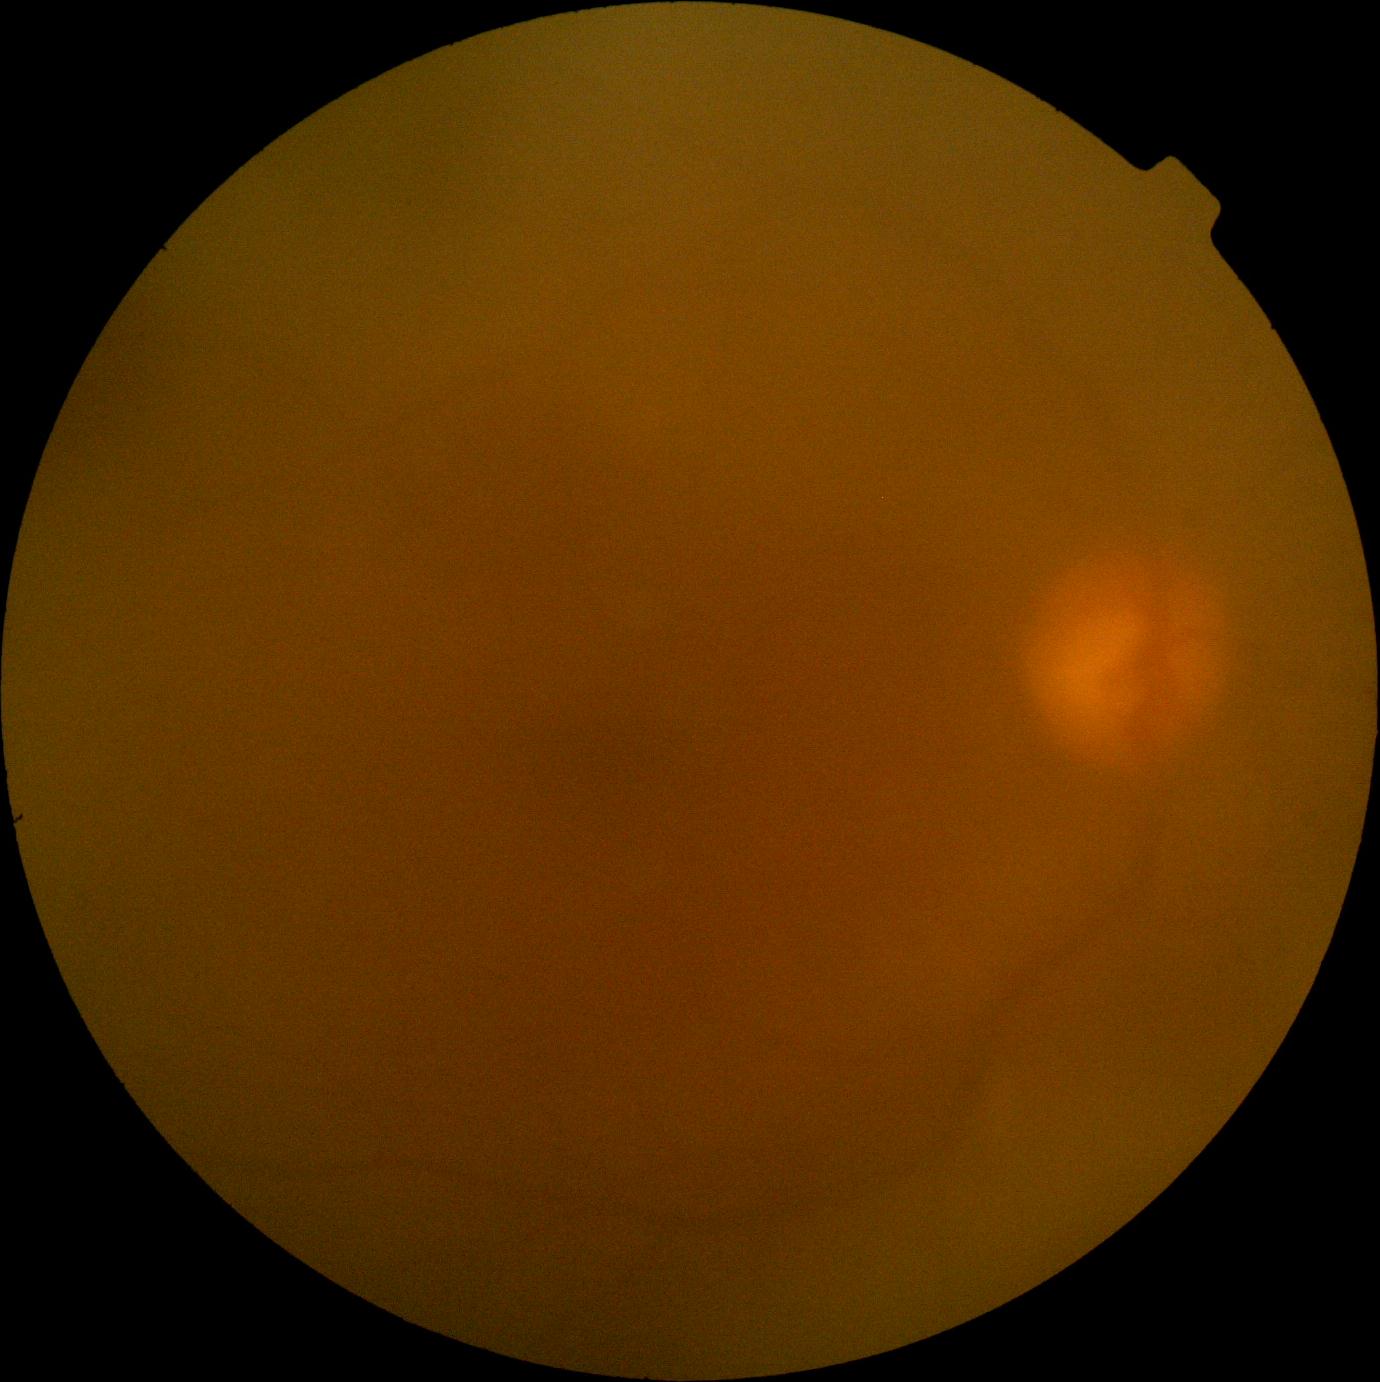

DR stage@ungradable due to poor image quality, image quality@insufficient.